Acquired with a NIDEK AFC-230 · CFP · image size 848x848 · DR severity per modified Davis staging
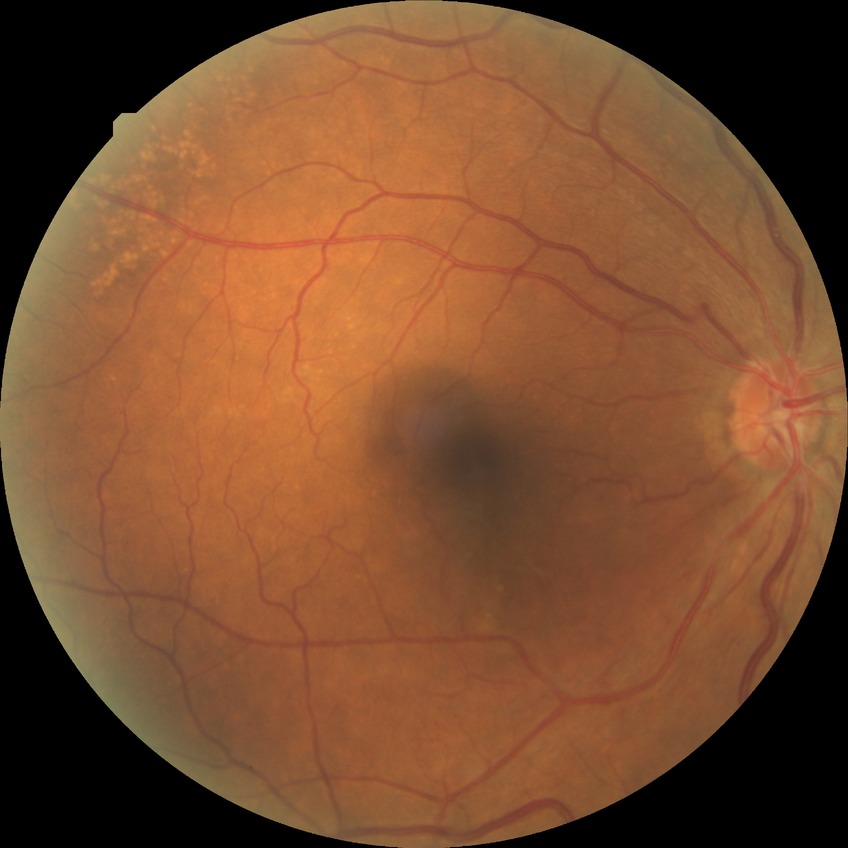 Annotations:
– diabetic retinopathy (DR) — NDR (no diabetic retinopathy)